Wide-field retinal mosaic image · image size 1924x1556 — 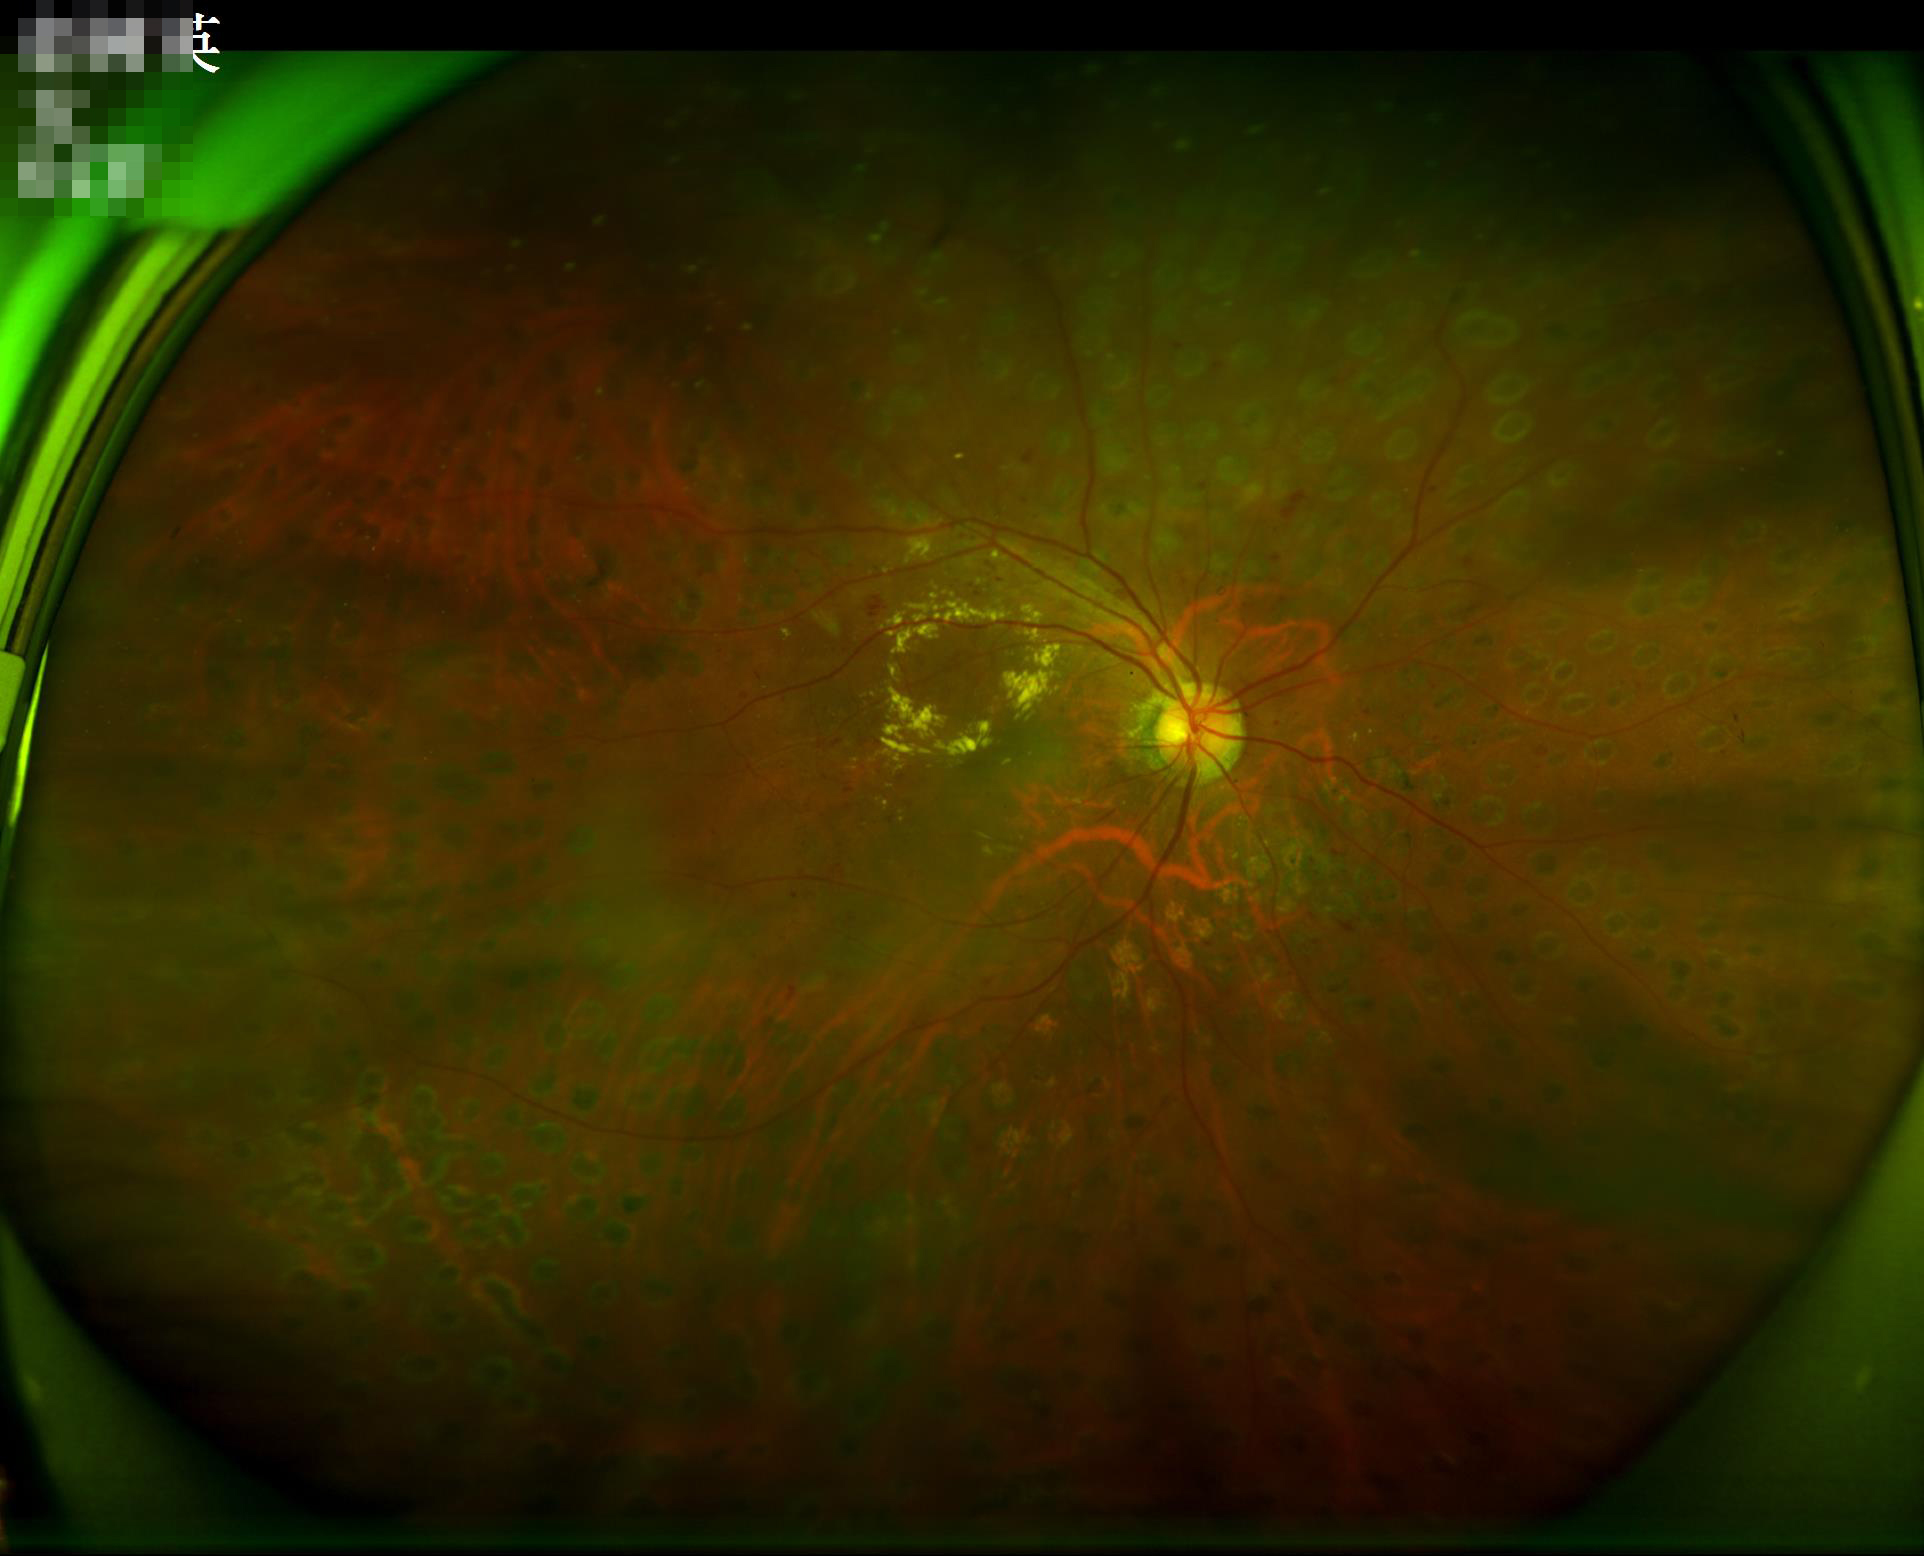
Overall image quality = acceptable | Illumination = uneven | Focus = sharp.